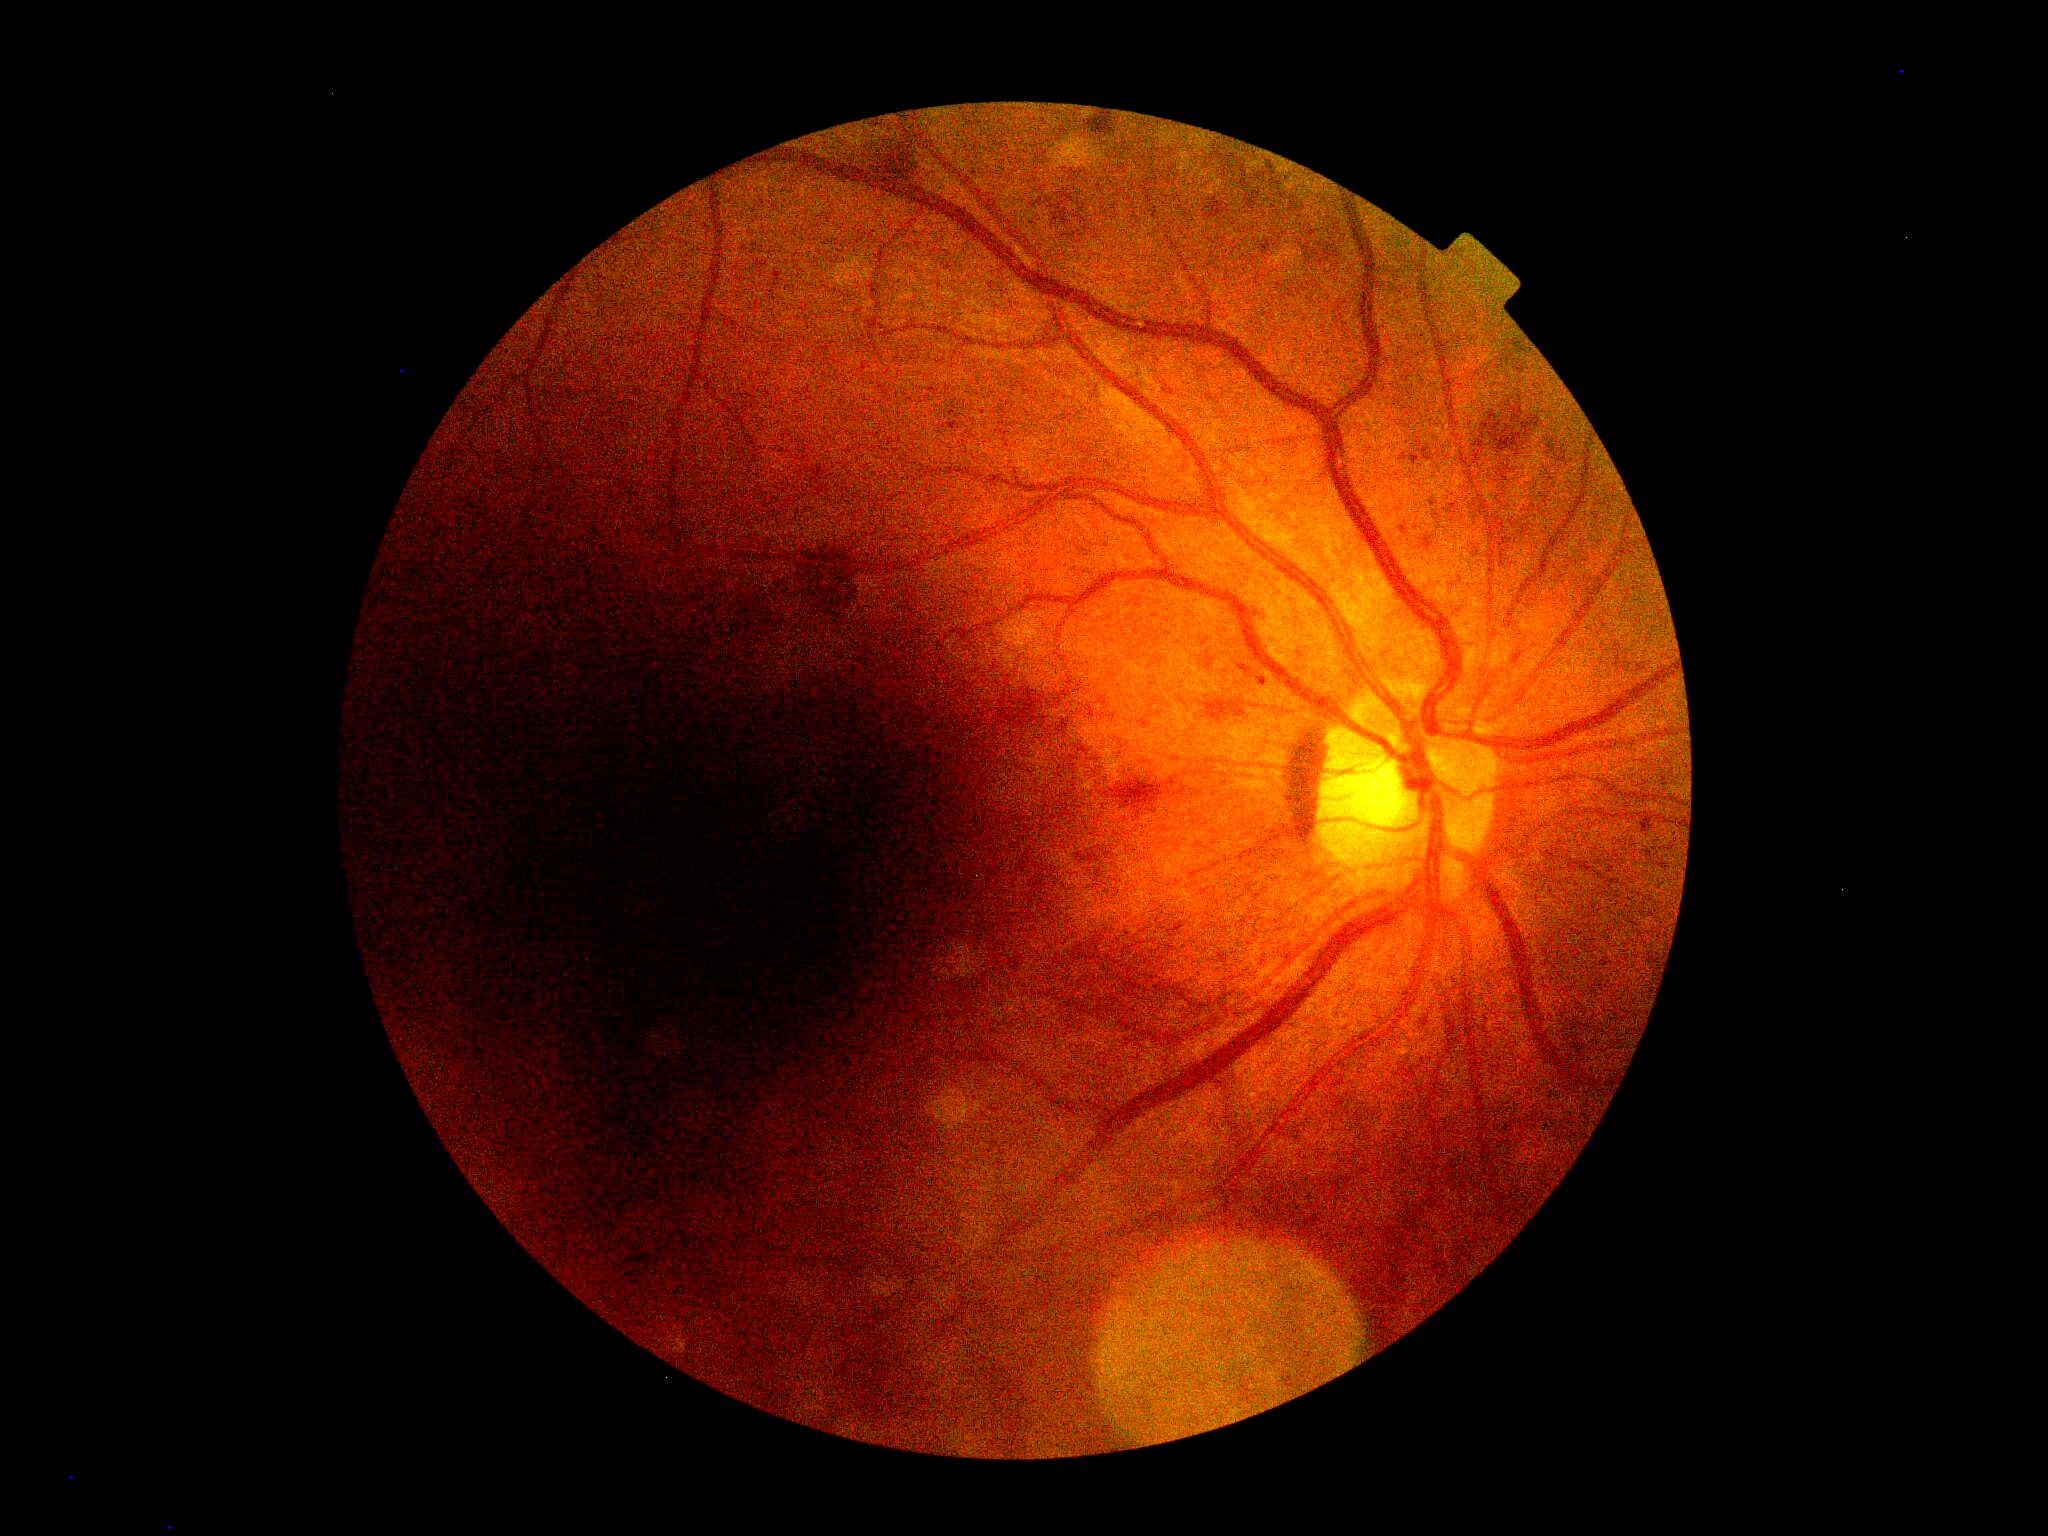

Retinopathy grade is moderate NPDR (2).